Wide-field contact fundus photograph of an infant. Clarity RetCam 3, 130° FOV. 640x480: 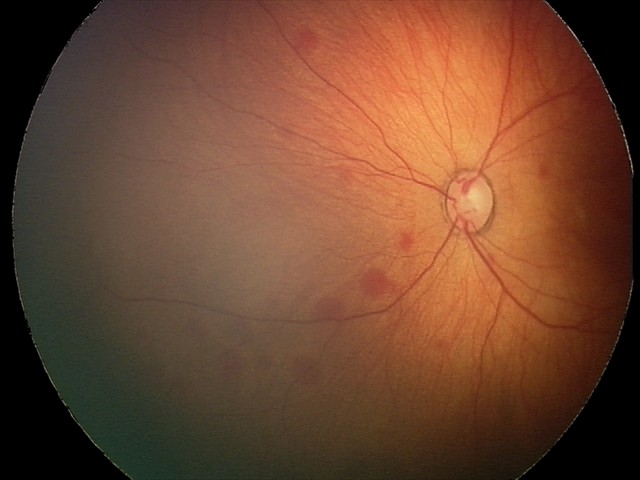 Series diagnosed as retinal hemorrhages.